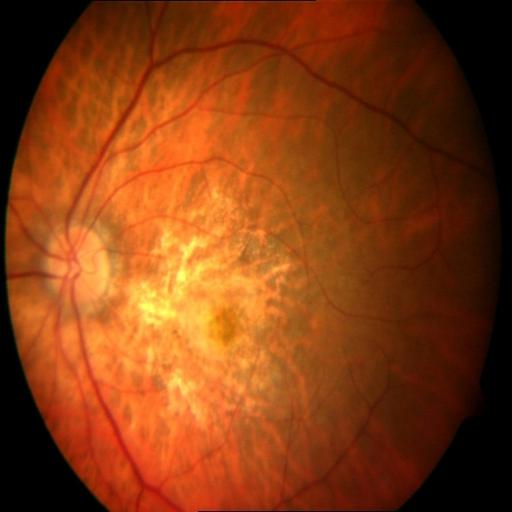

Findings: macular scar.